1924 by 1556 pixels · ultra-widefield fundus photograph: 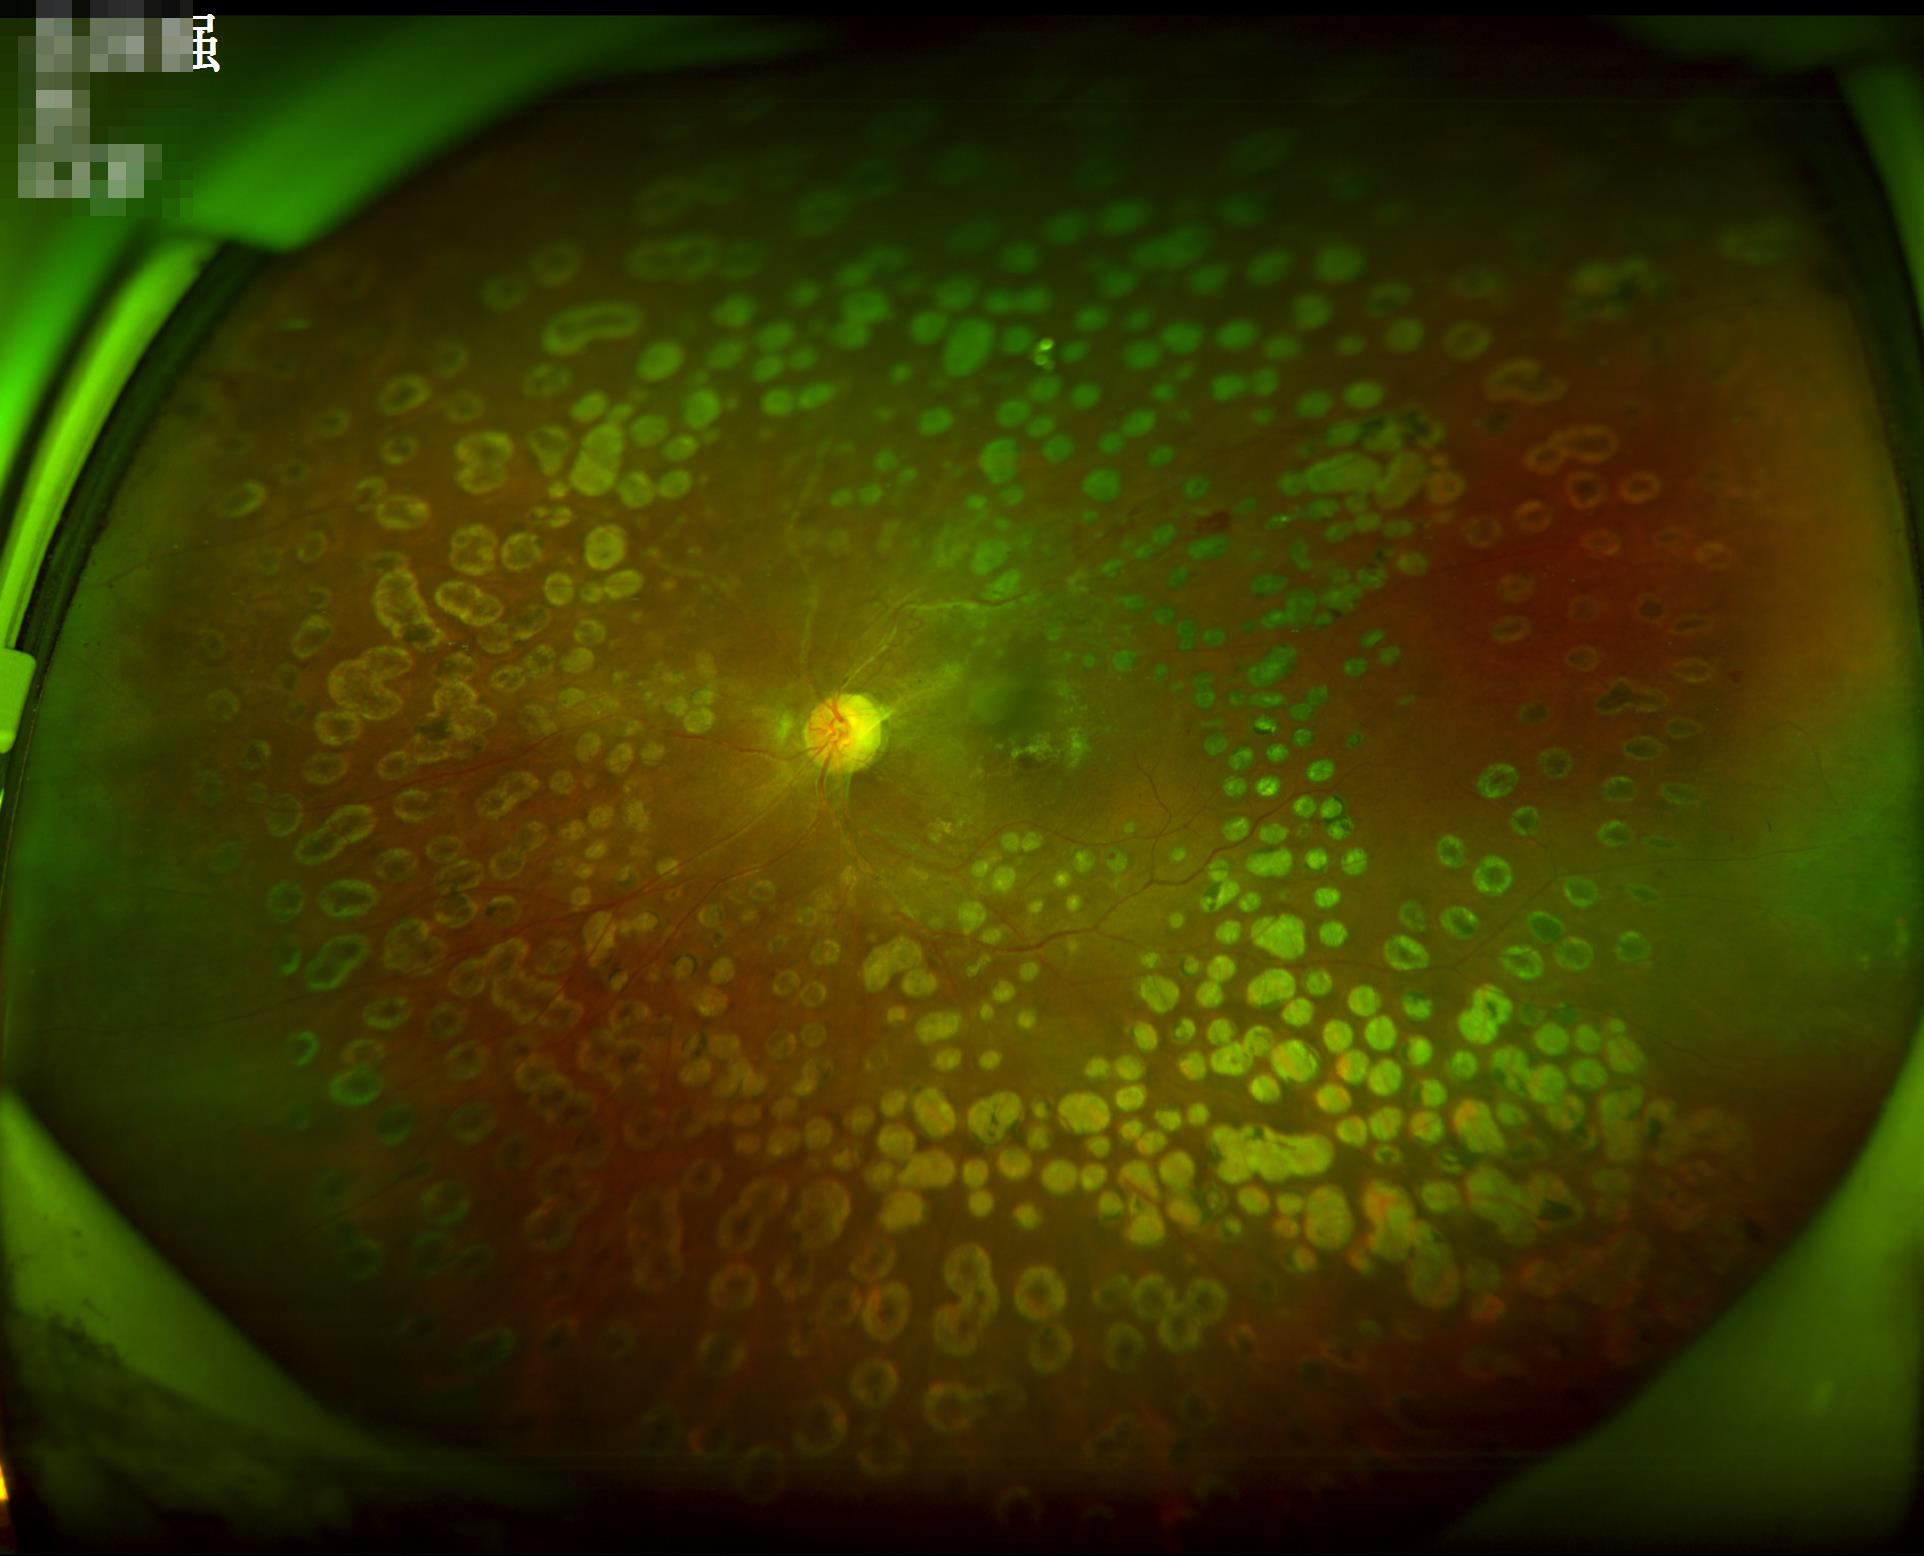

Out of focus; structures are indistinct. Contrast is low. Image quality is inadequate for diagnostic use.